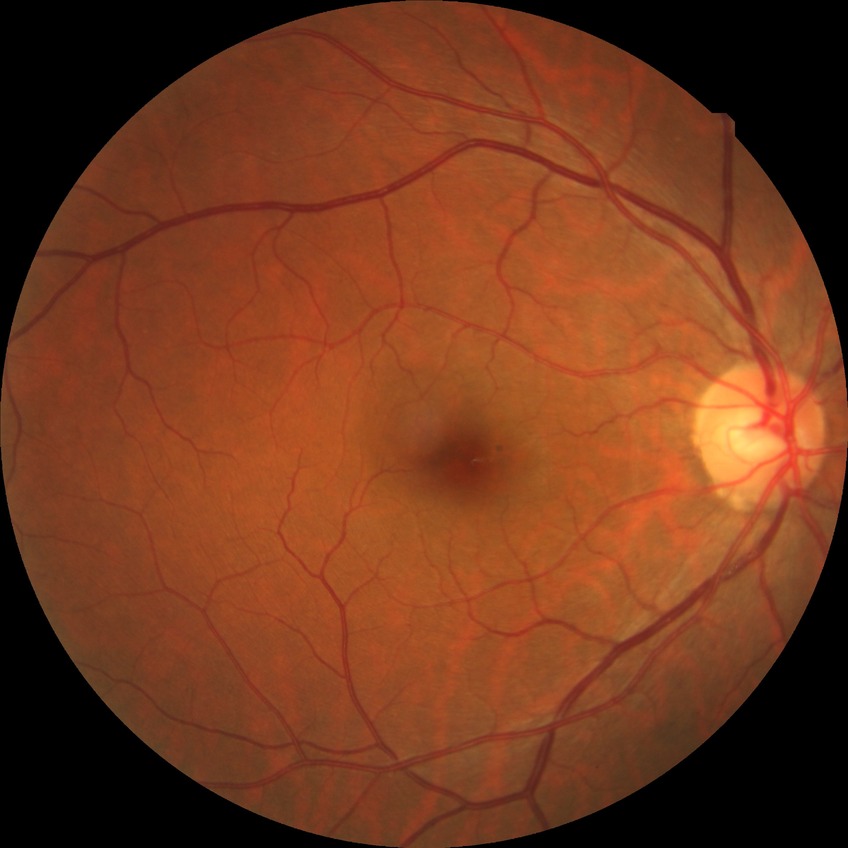
Diabetic retinopathy (DR): SDR (simple diabetic retinopathy).